45 degree fundus photograph: 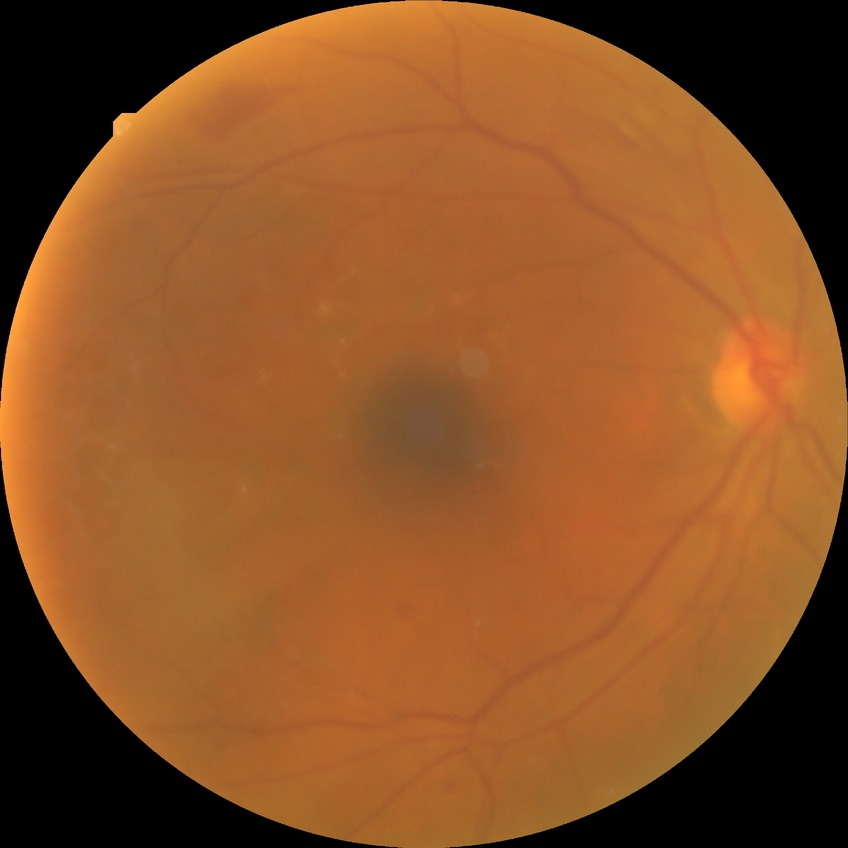 Diabetic retinopathy (DR): simple diabetic retinopathy (SDR).